2346x1568px.
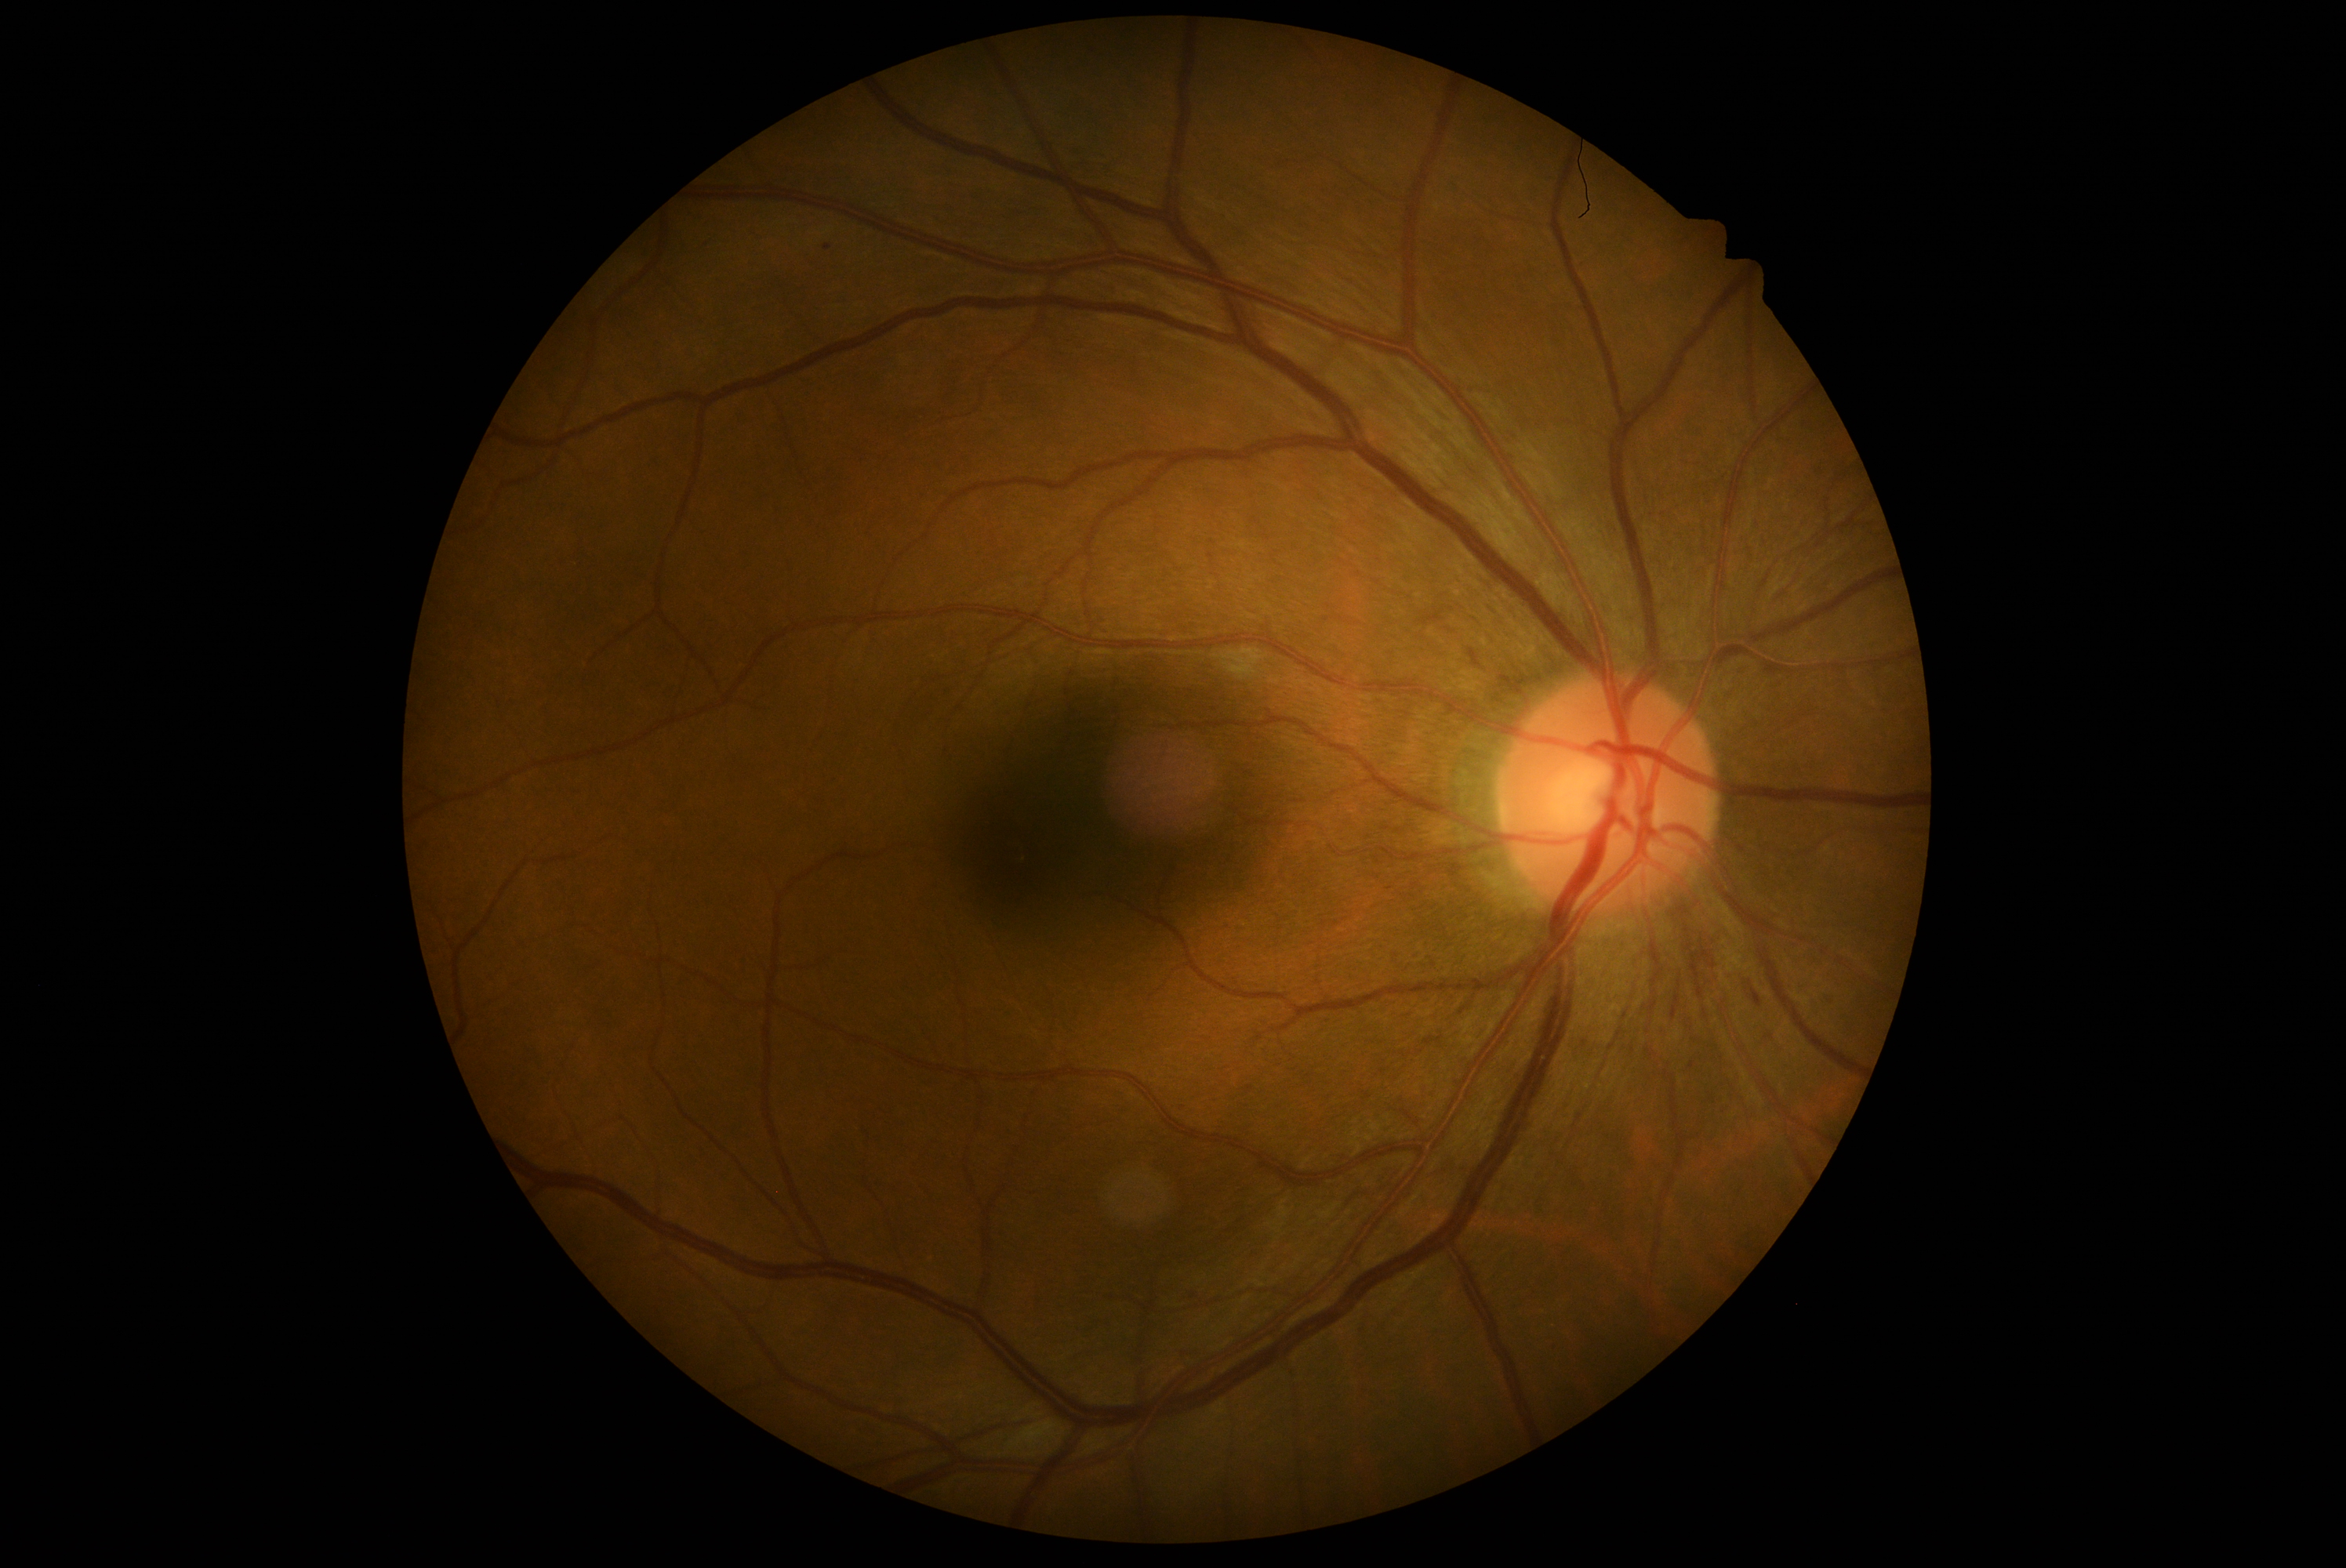 dr_grade: grade 2 (moderate NPDR)
dr_category: non-proliferative diabetic retinopathy